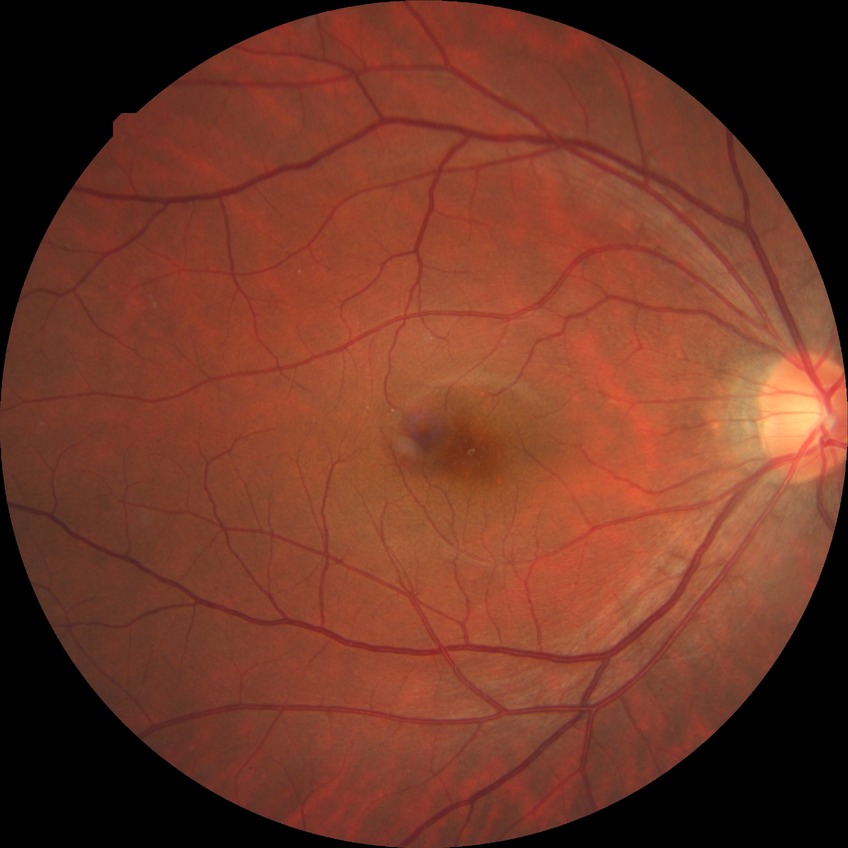
davis_grade: no diabetic retinopathy